Fundus photo:
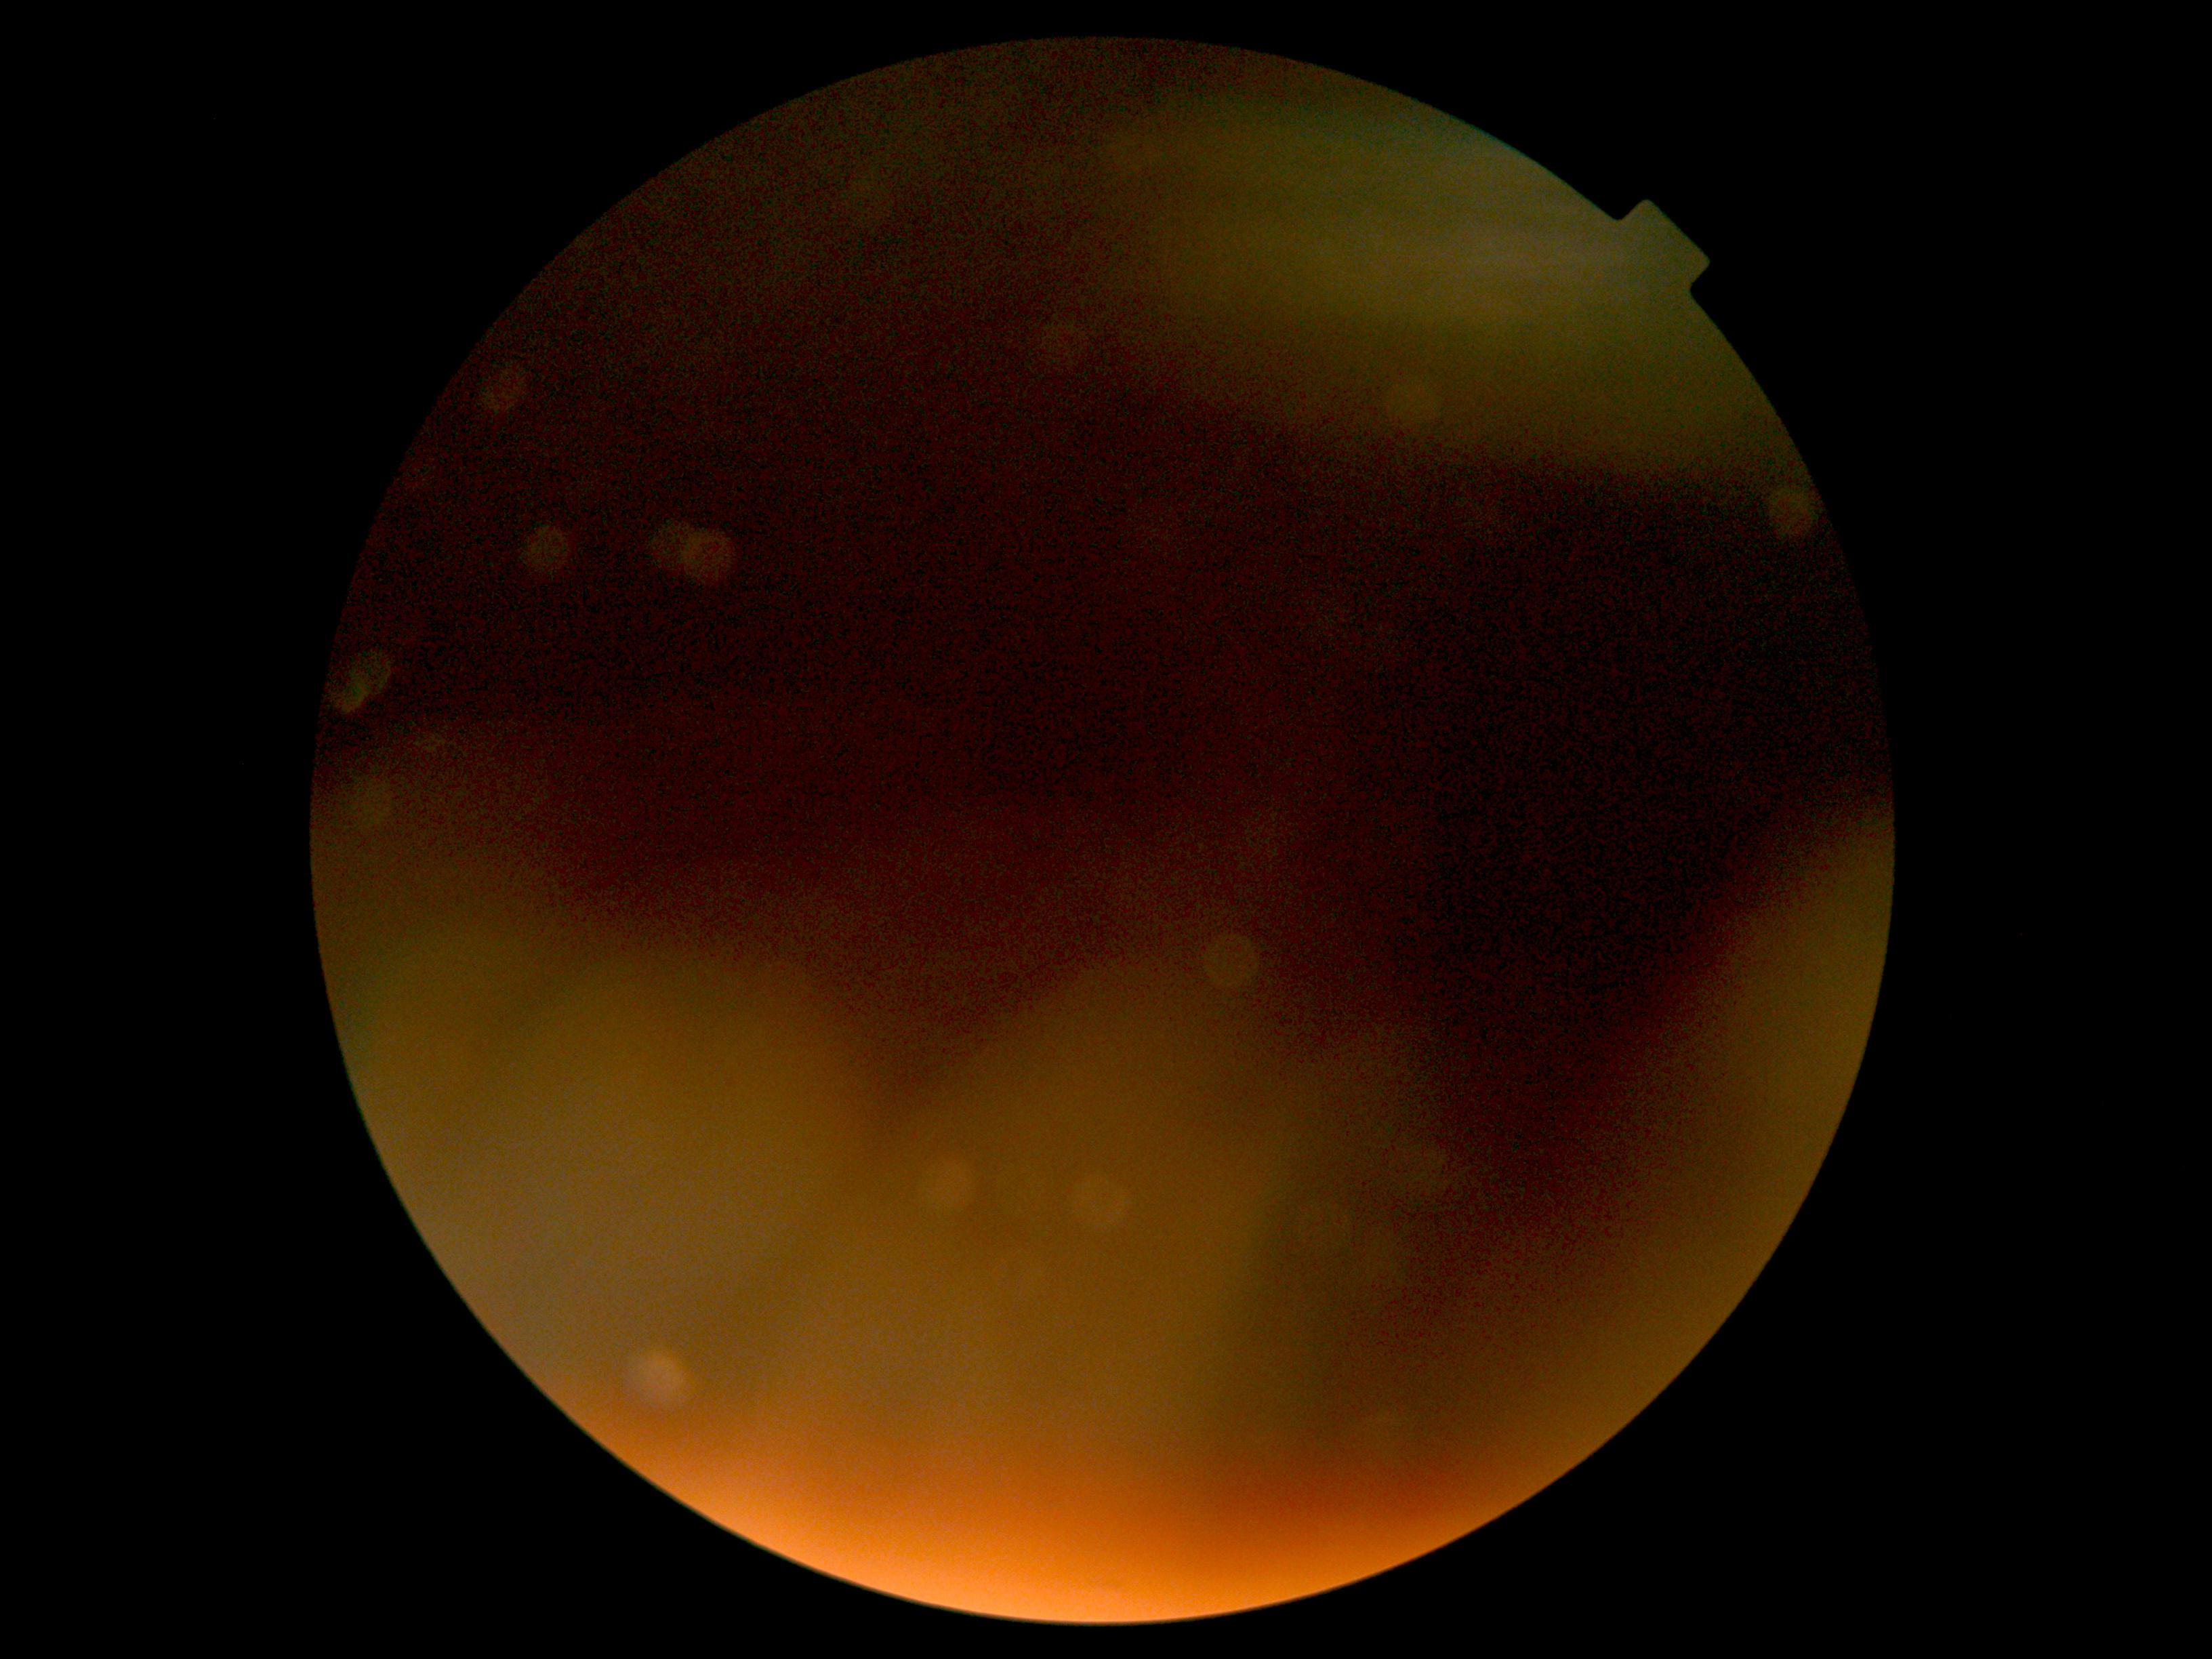

diabetic retinopathy severity@ungradable.